Color fundus image
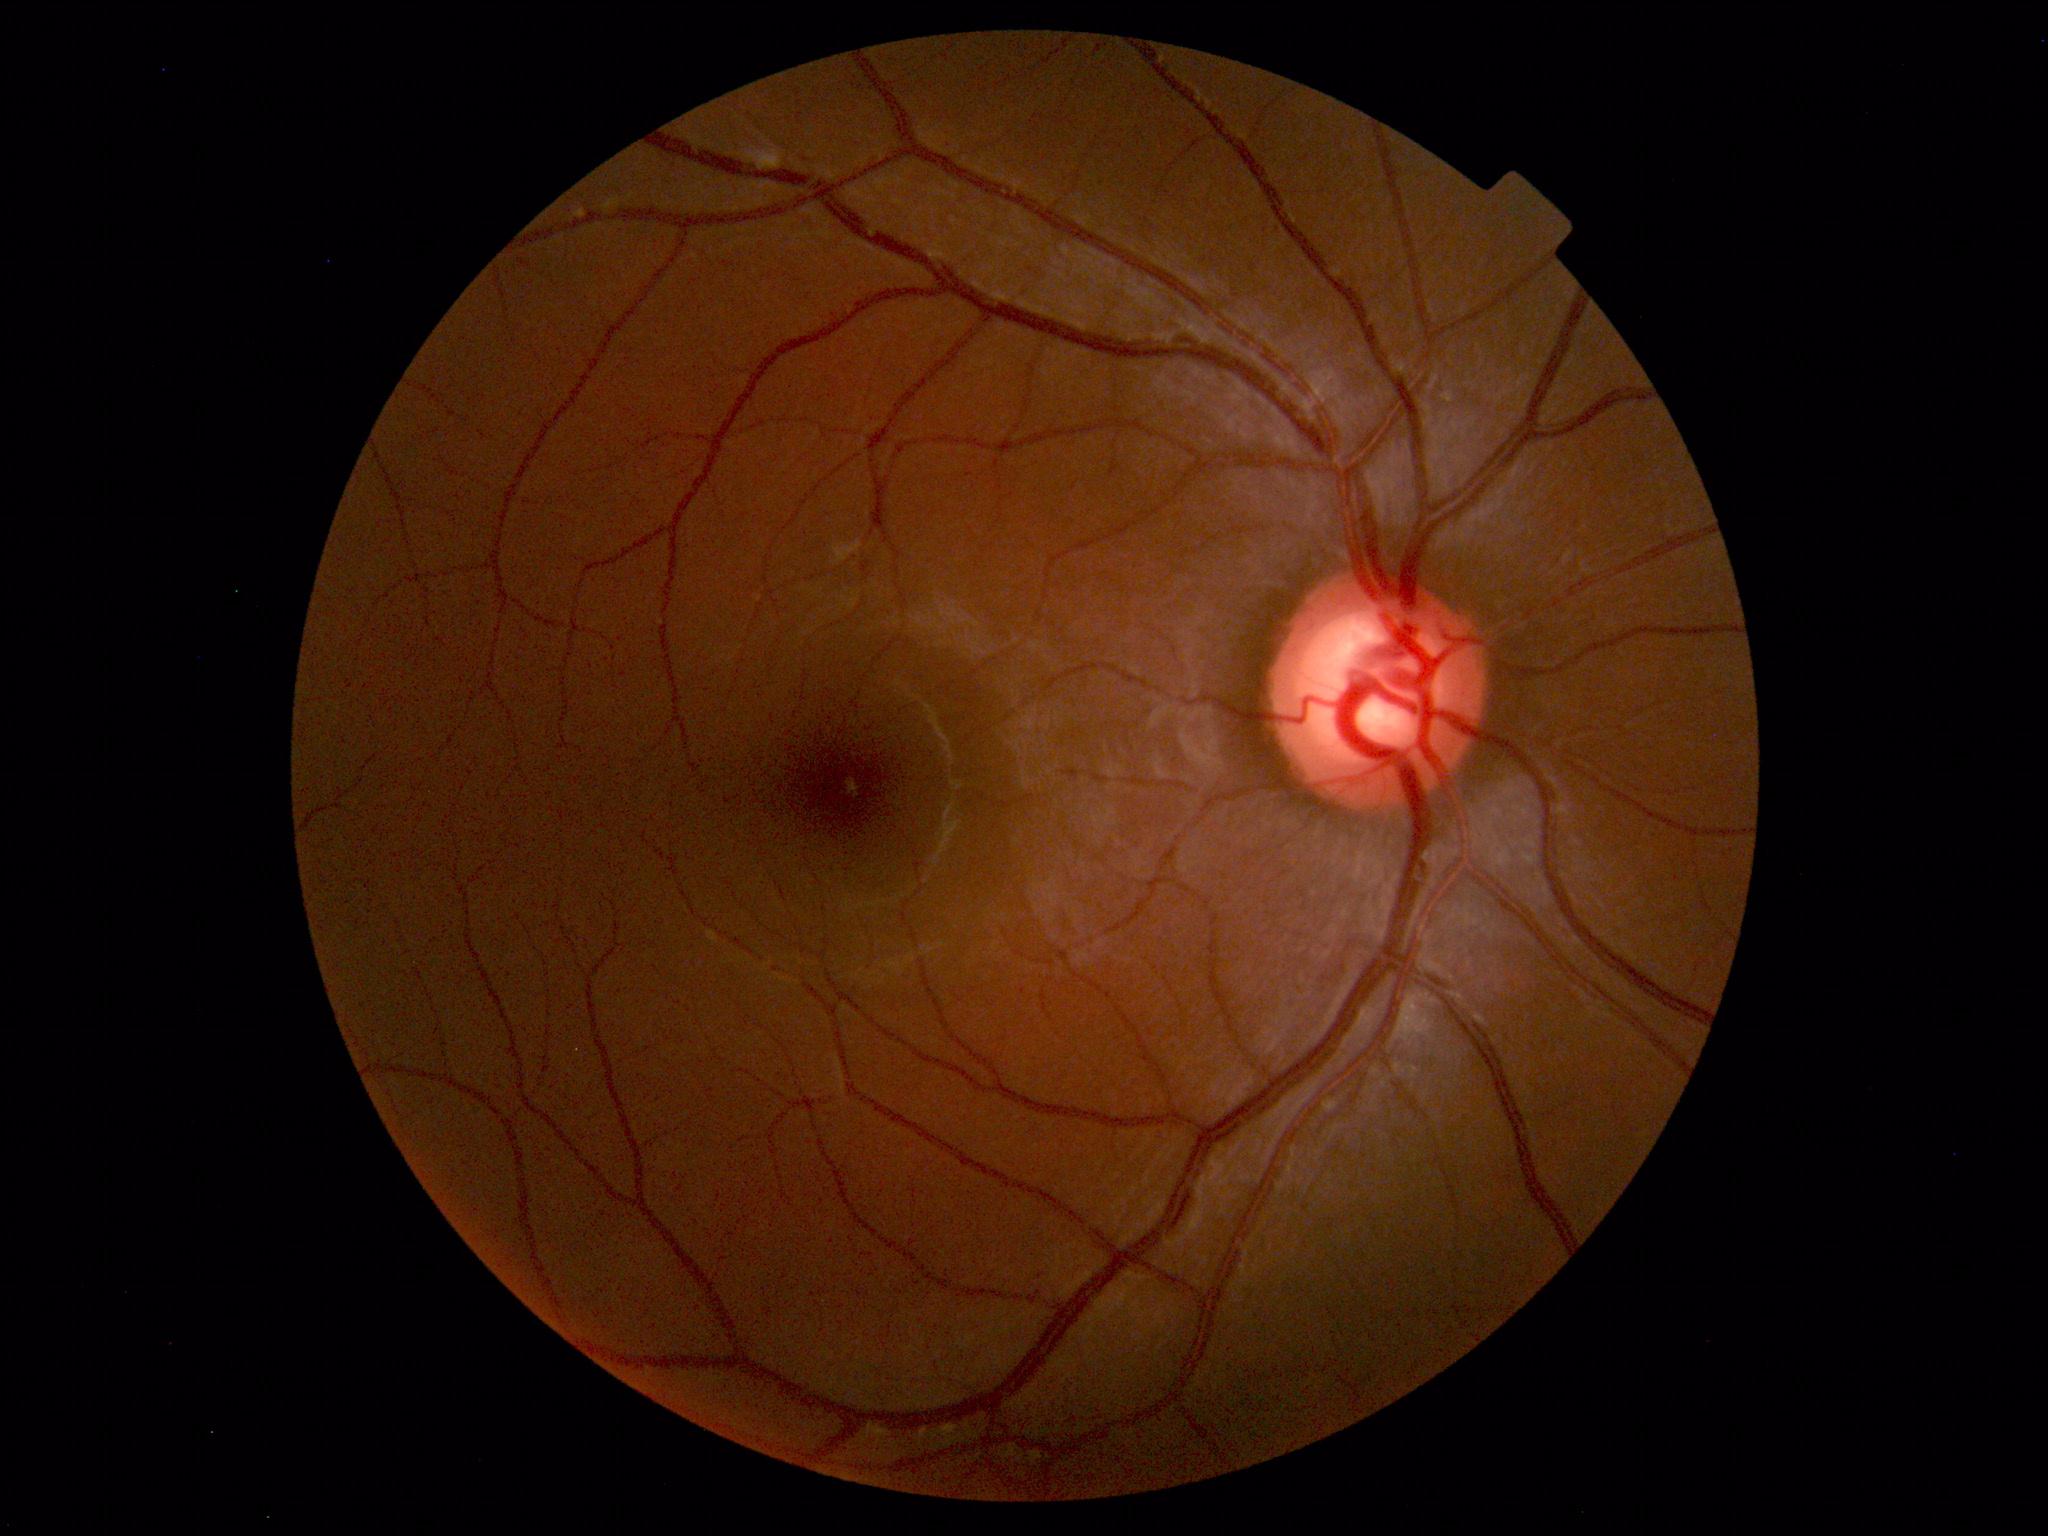
The fundus appears normal with no pathological findings.